Camera: Topcon TRC-NW8.
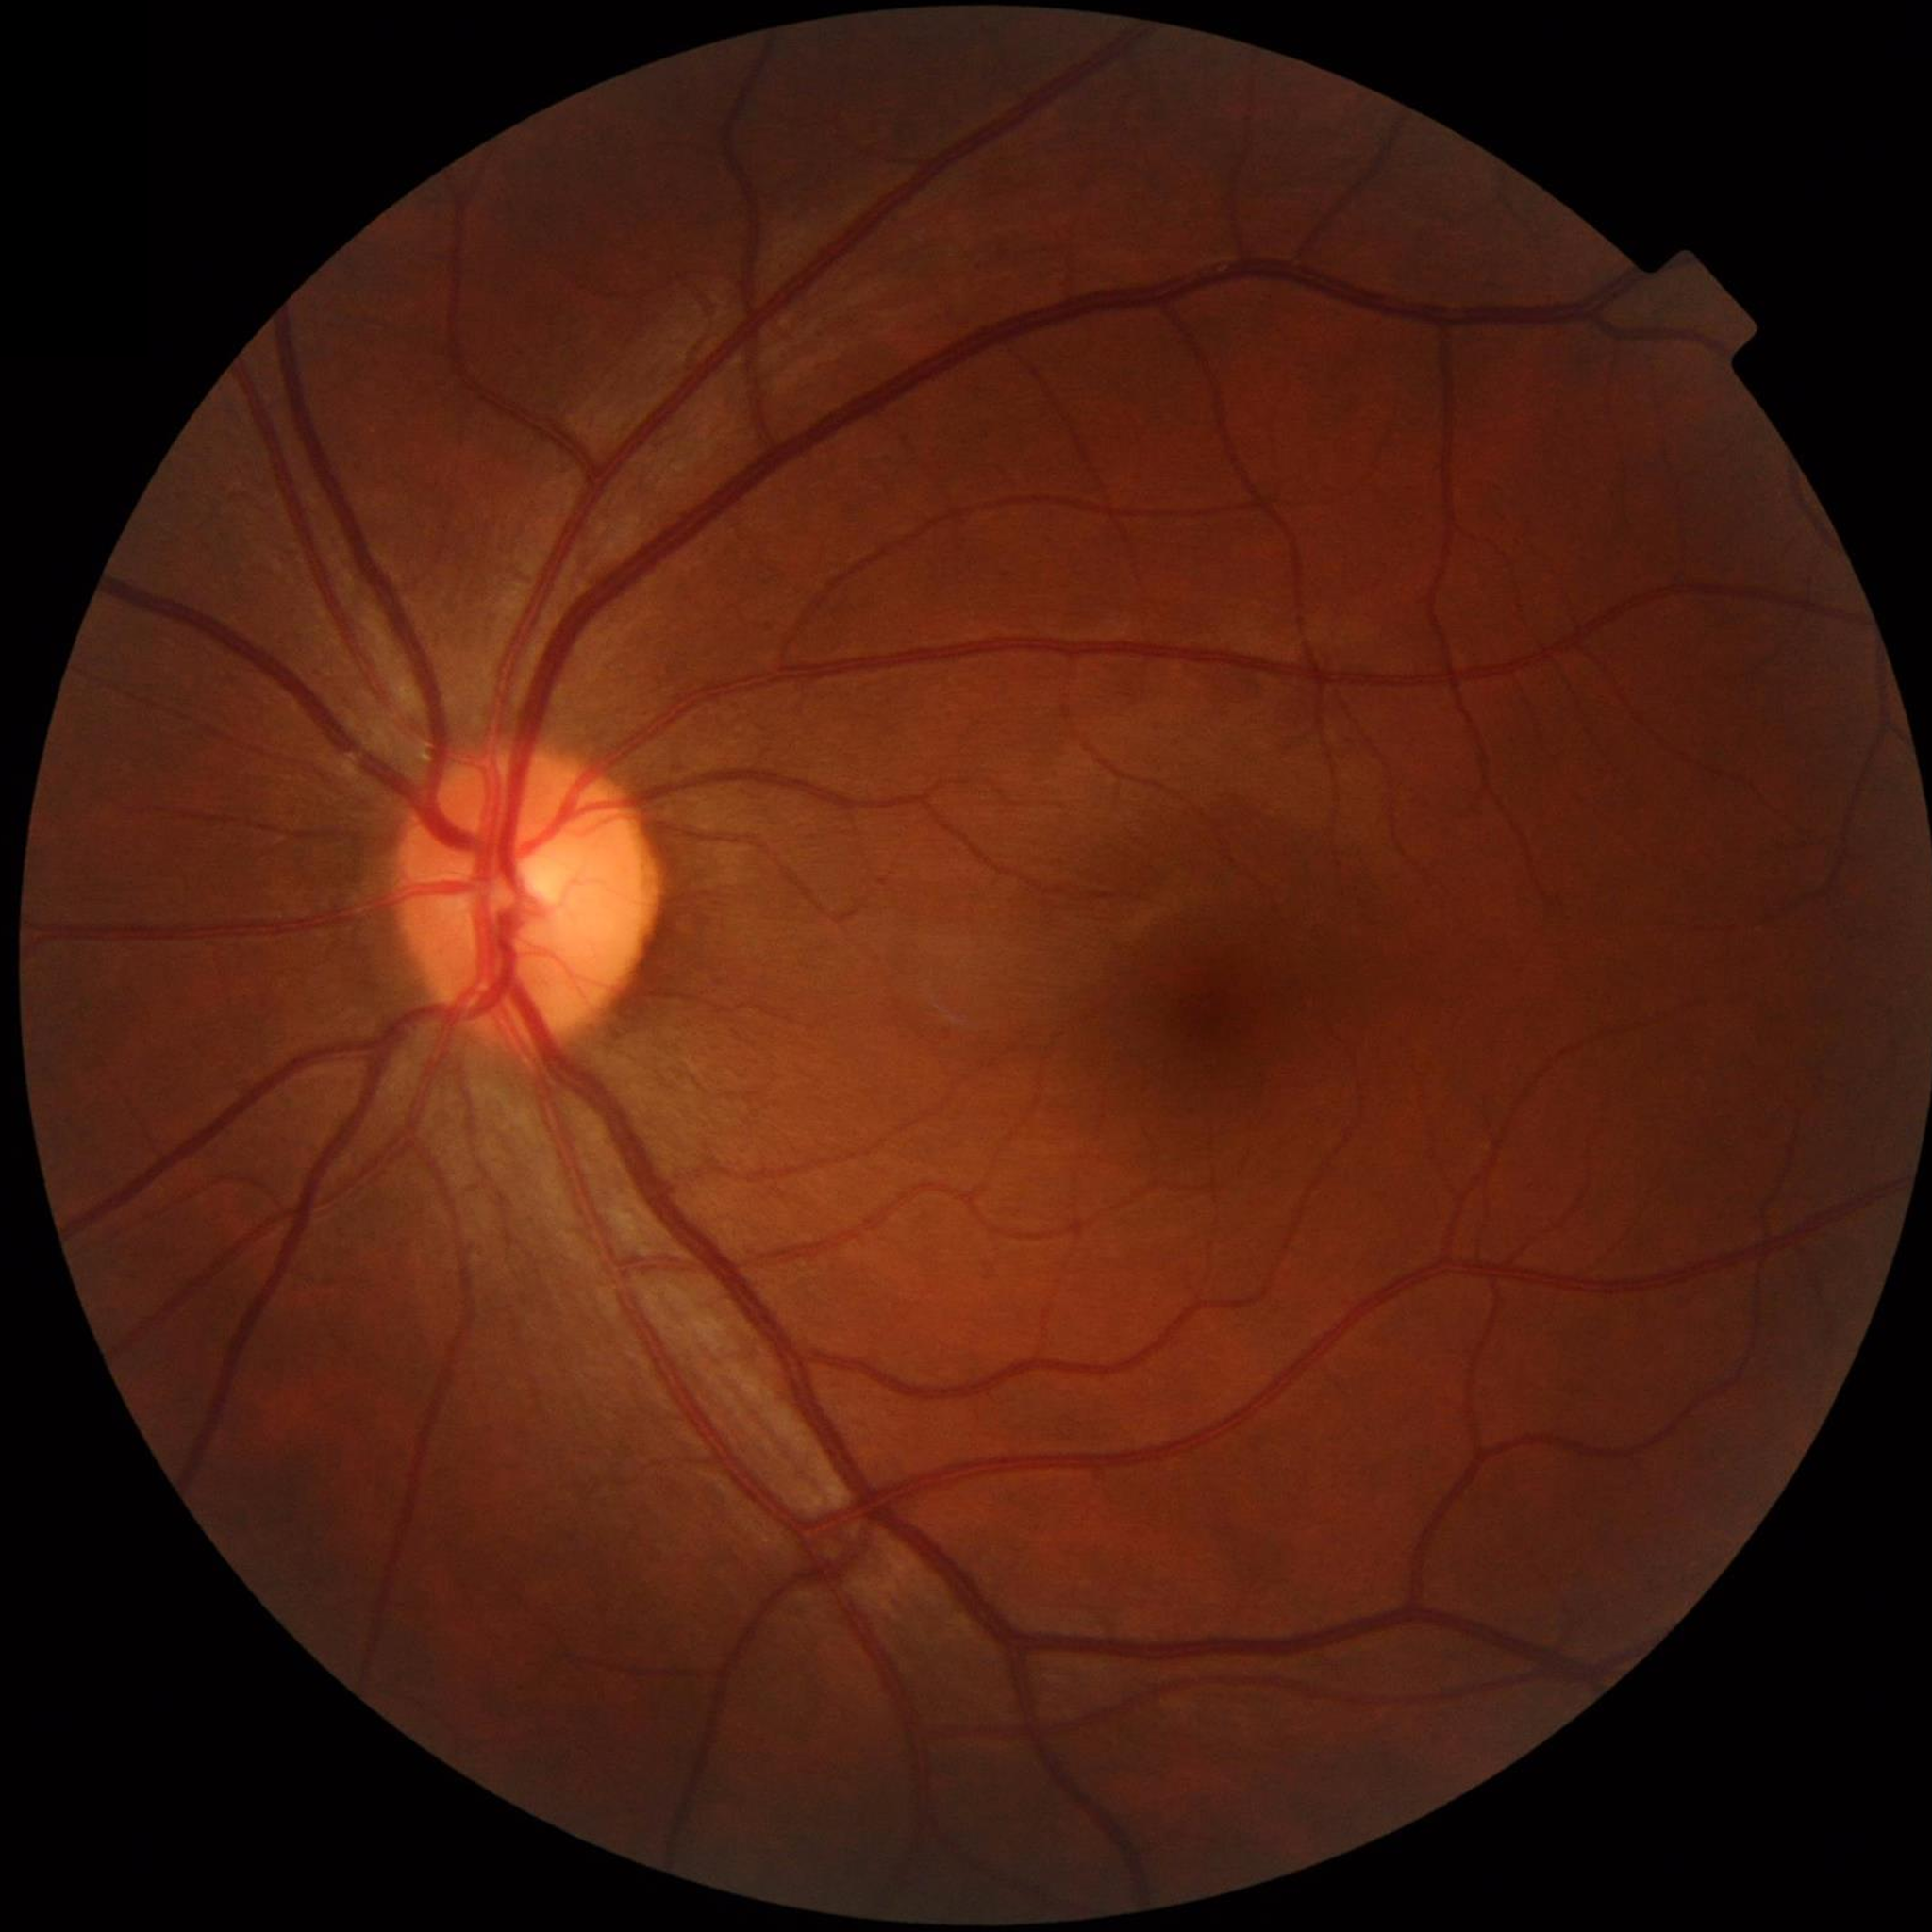 Color fundus photo from a control patient without diagnosed retinal disease.